Infant wide-field fundus photograph.
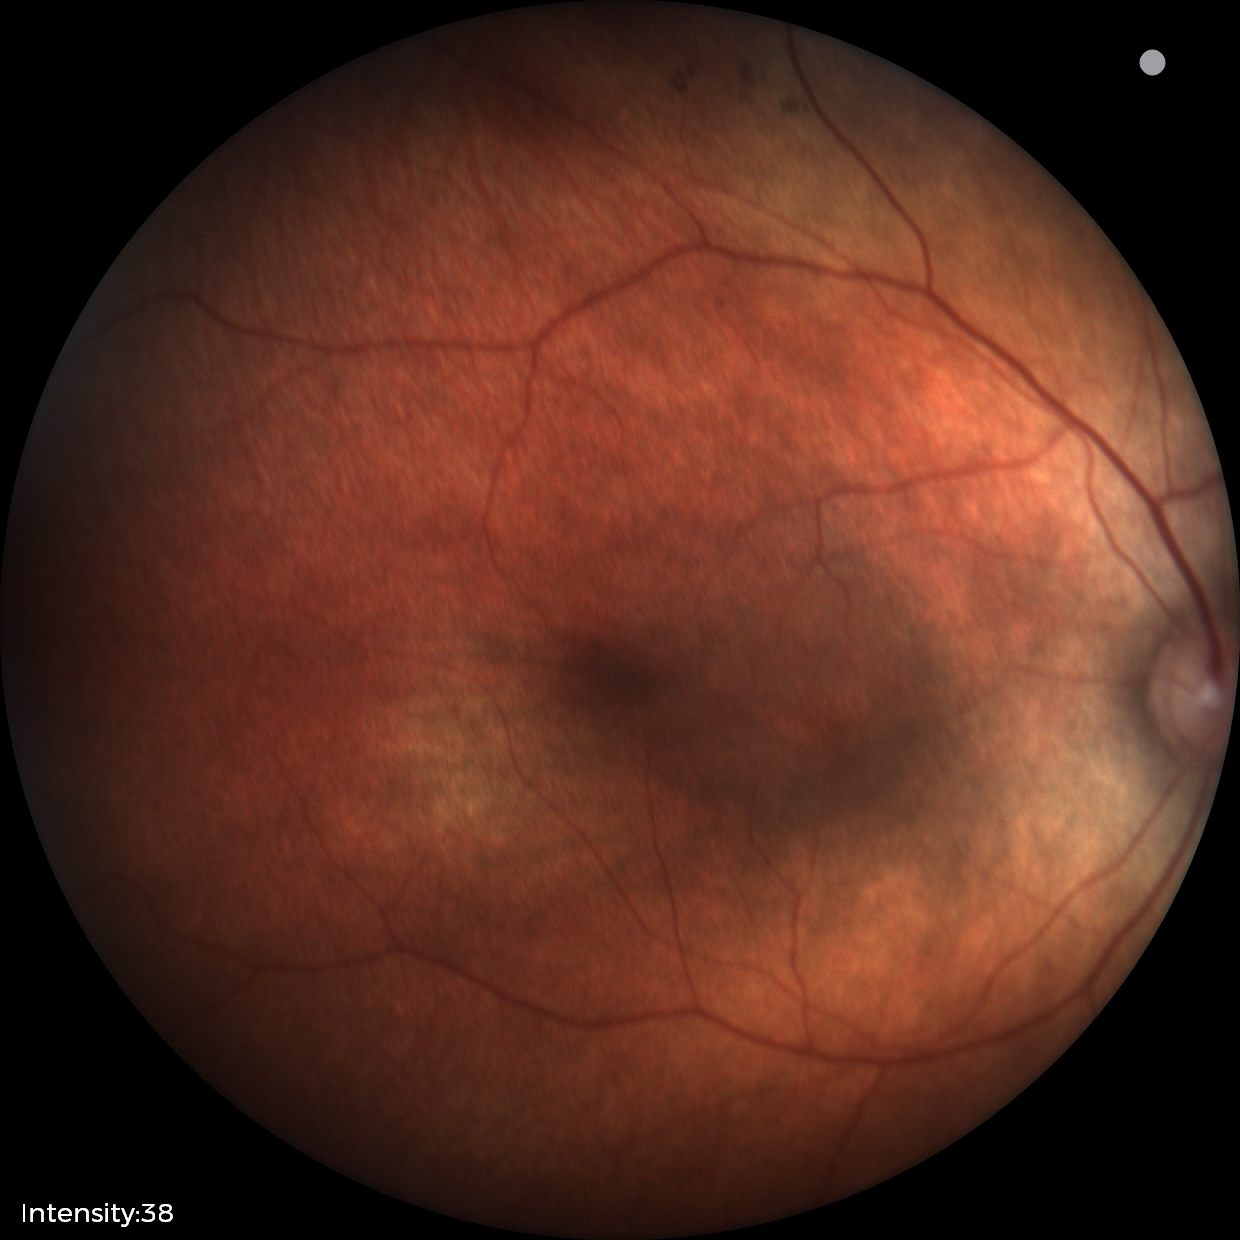 Impression = normal retinal appearance